Fundus photo. 2352x1568:
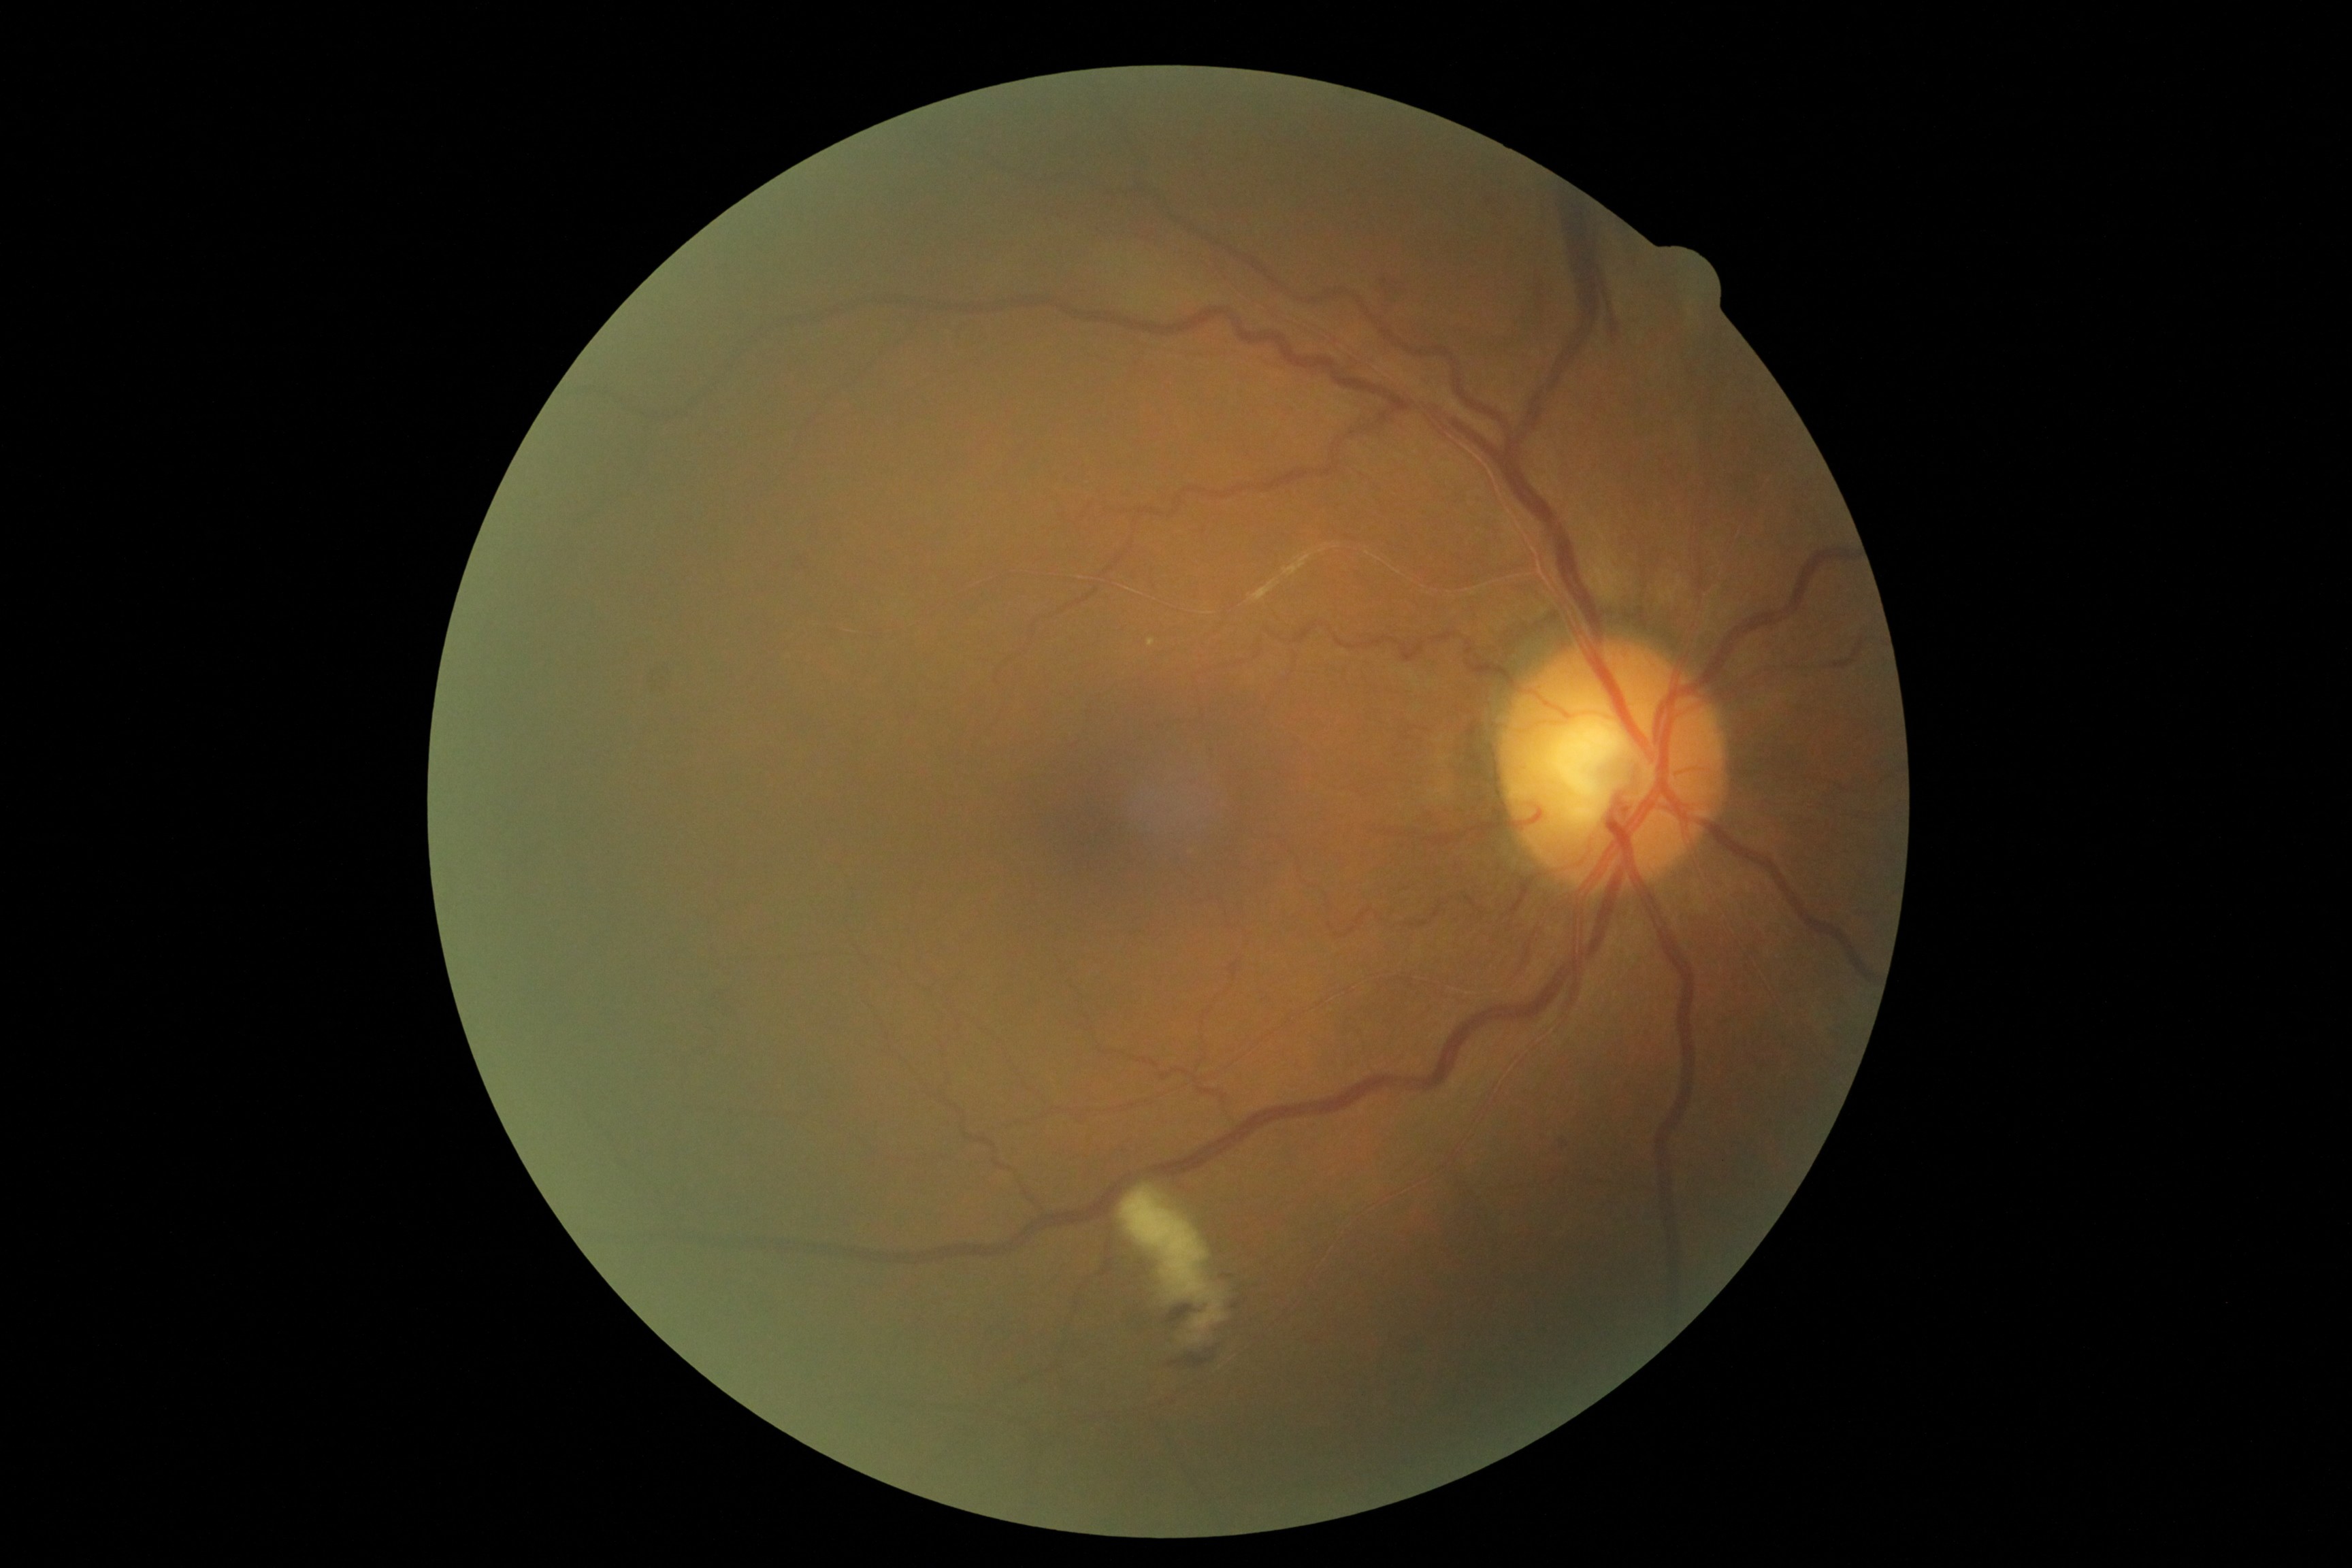
Retinopathy: grade 2 (moderate NPDR).